Pediatric wide-field fundus photograph; 130° field of view (Clarity RetCam 3) — 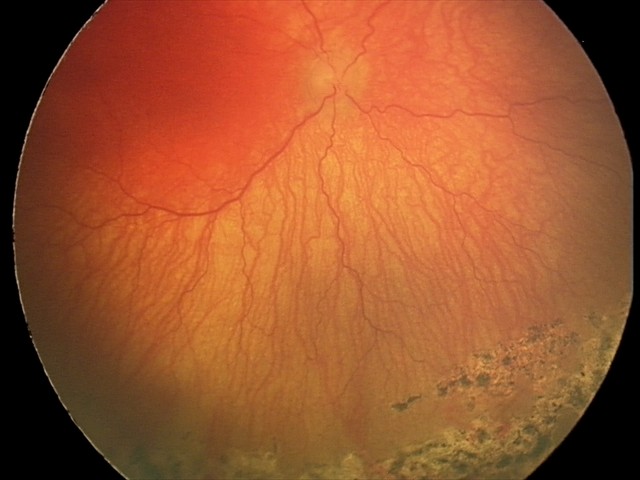
From an examination with diagnosis of A-ROP (aggressive ROP).